848 x 848 pixels; NIDEK AFC-230.
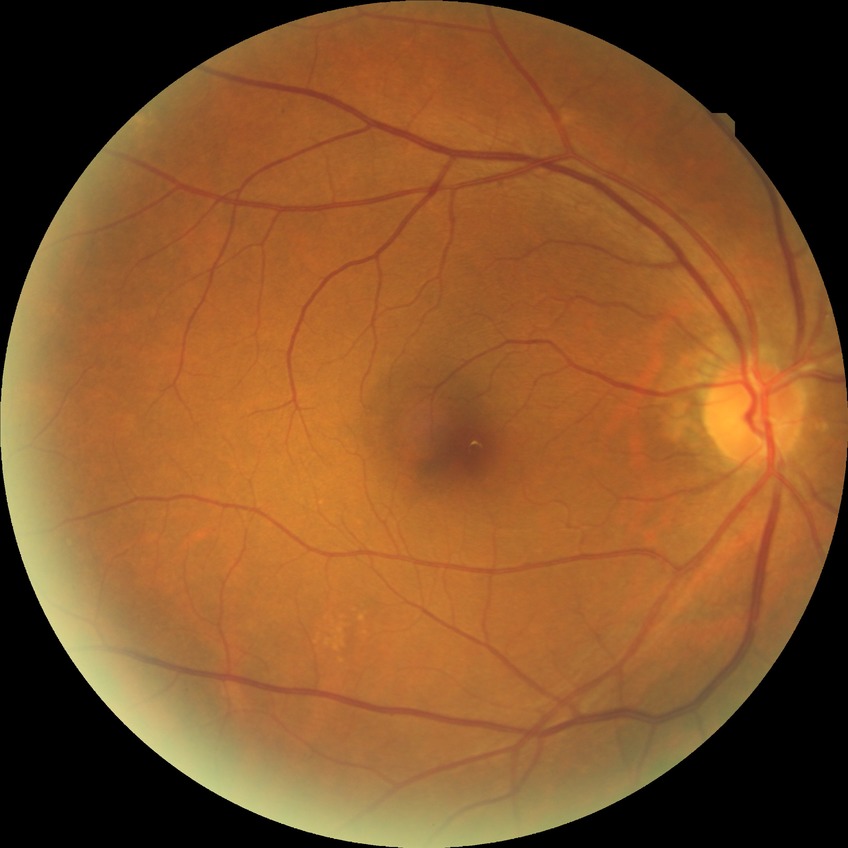
  davis_grade: no diabetic retinopathy